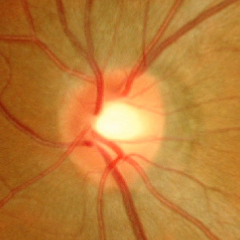

Assessment = no evidence of glaucoma.